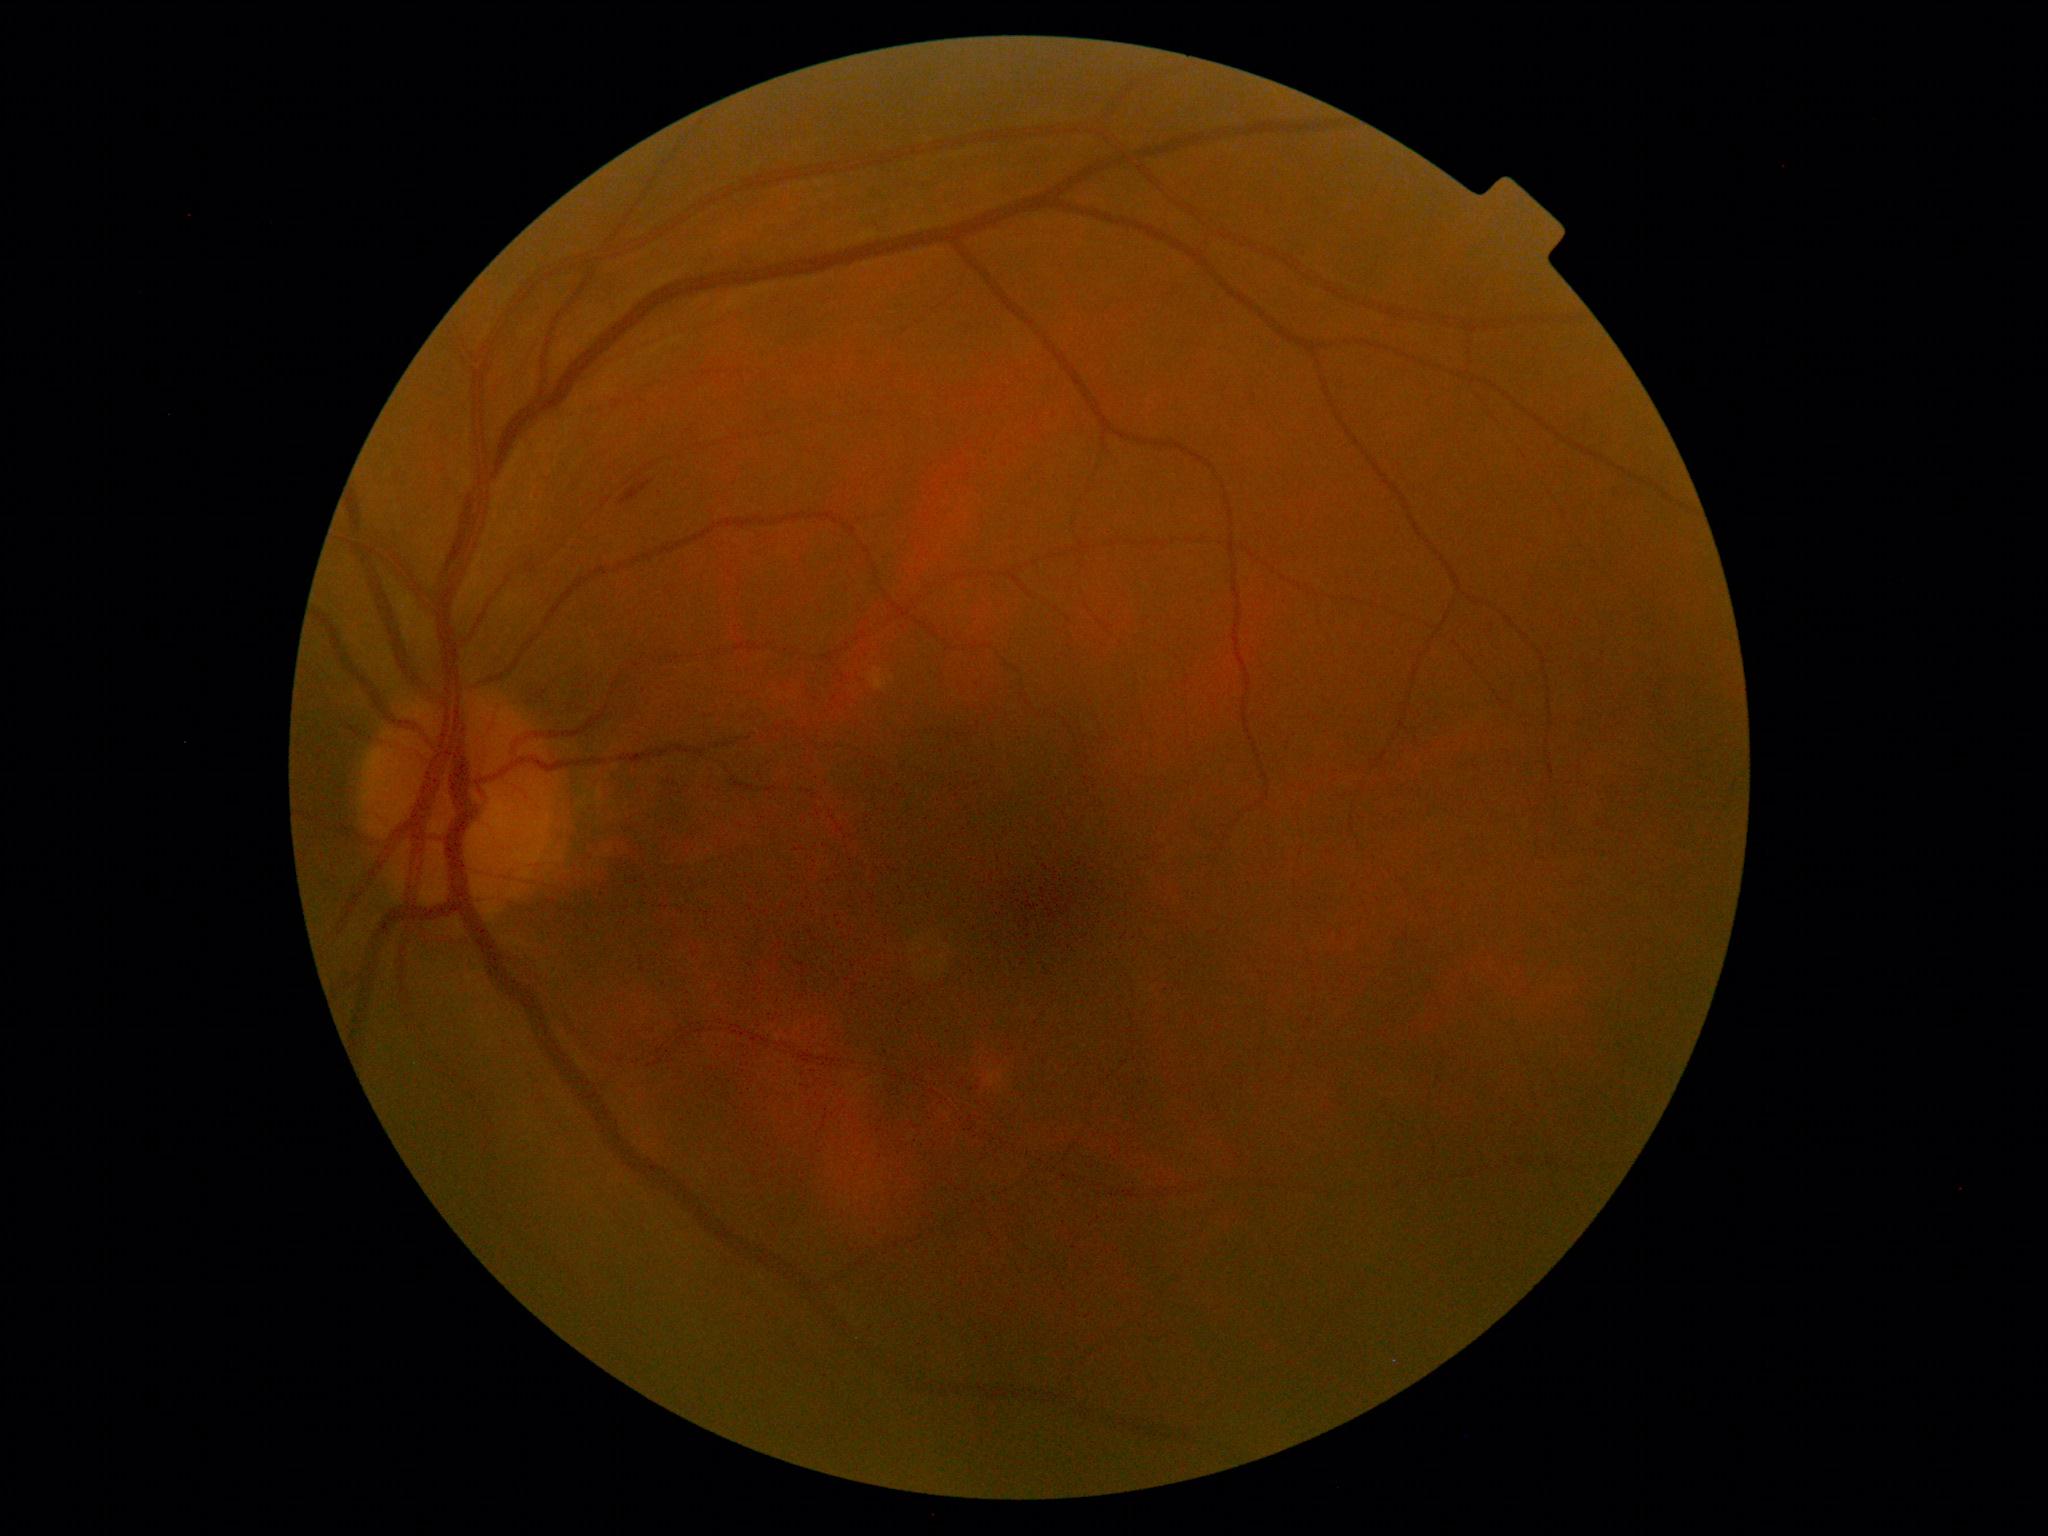

DR grade is 2 (moderate NPDR). DR class: non-proliferative diabetic retinopathy.